RetCam wide-field infant fundus image — 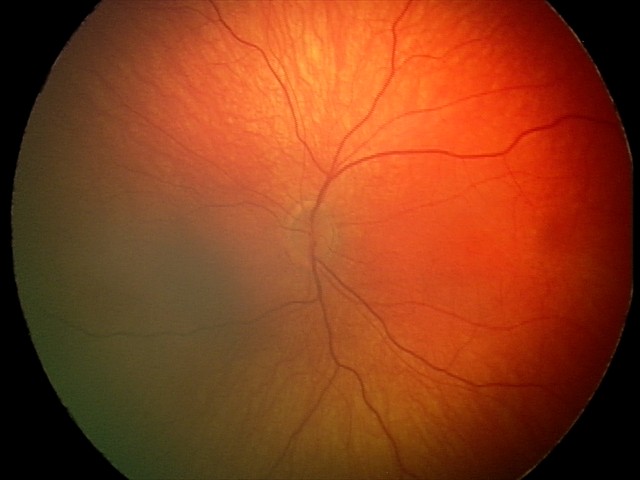
Diagnosis from this screening exam: retinal hemorrhages.